Fundus photo; man; 2212x1661px; intraocular pressure 10 mmHg.
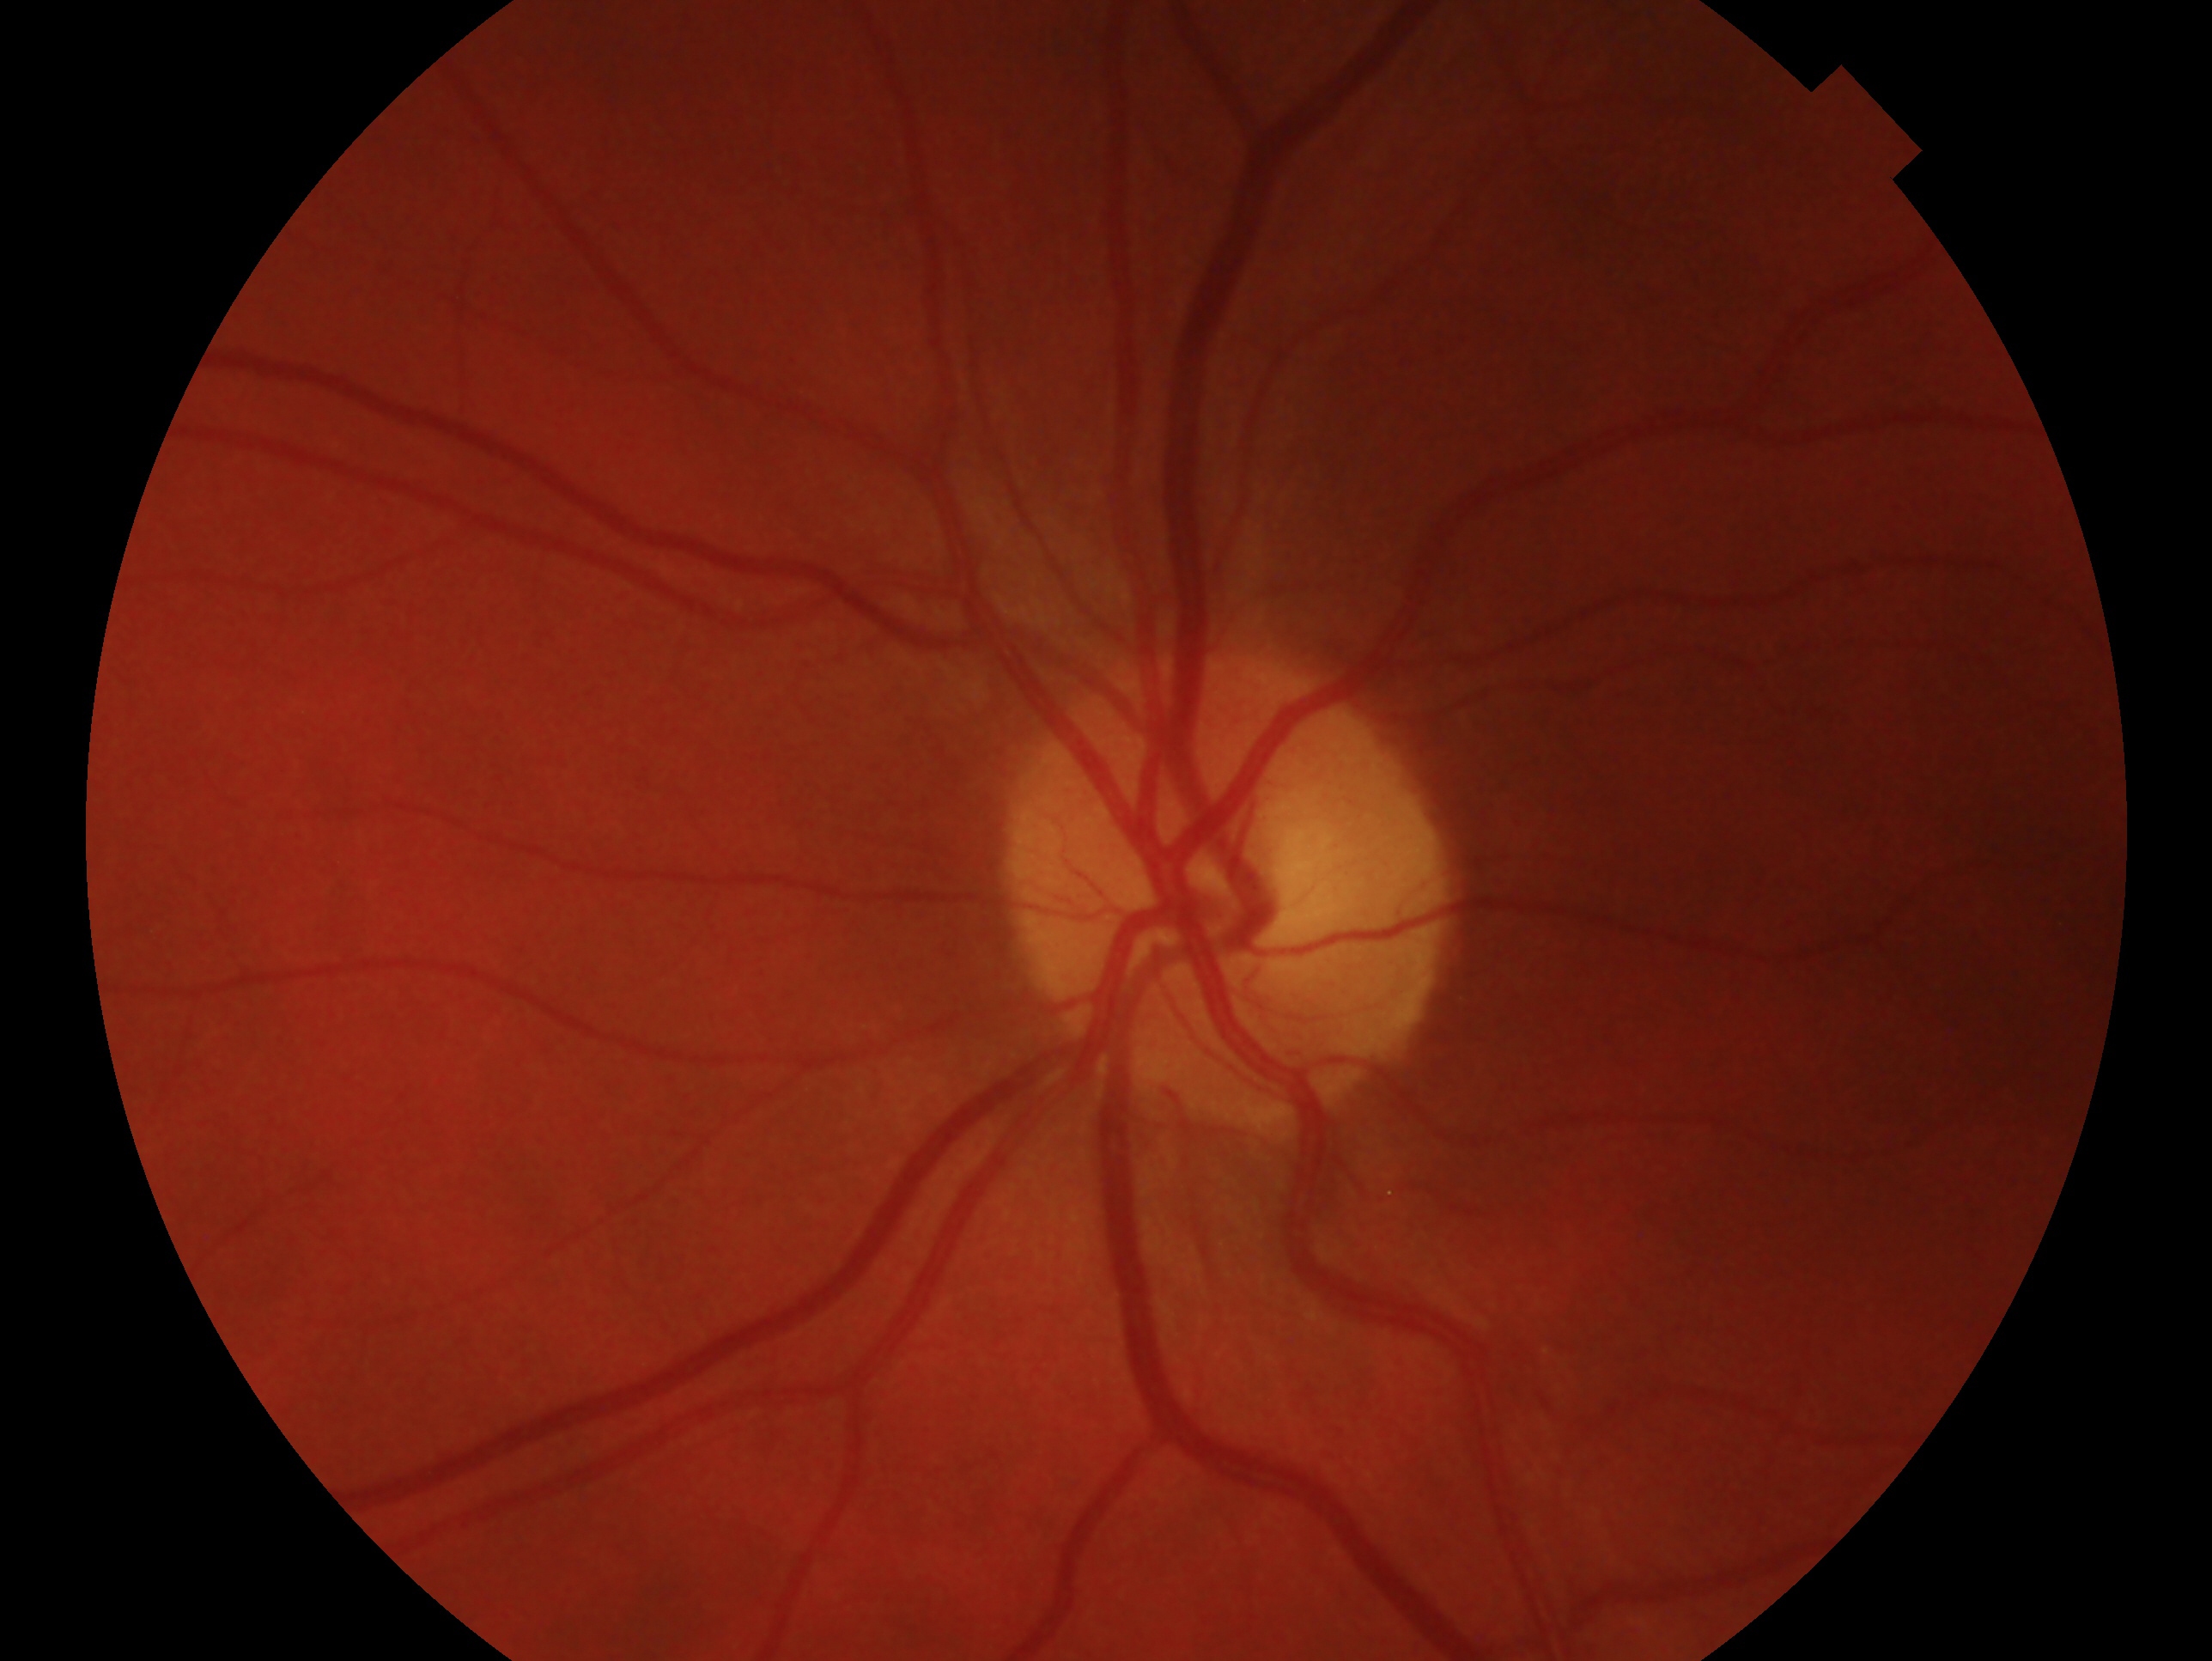 Glaucoma status: no signs of glaucoma.
Eye: oculus sinister.